Diabetic retinopathy graded by the modified Davis classification · 848x848 · nonmydriatic · 45° FOV · acquired with a NIDEK AFC-230: 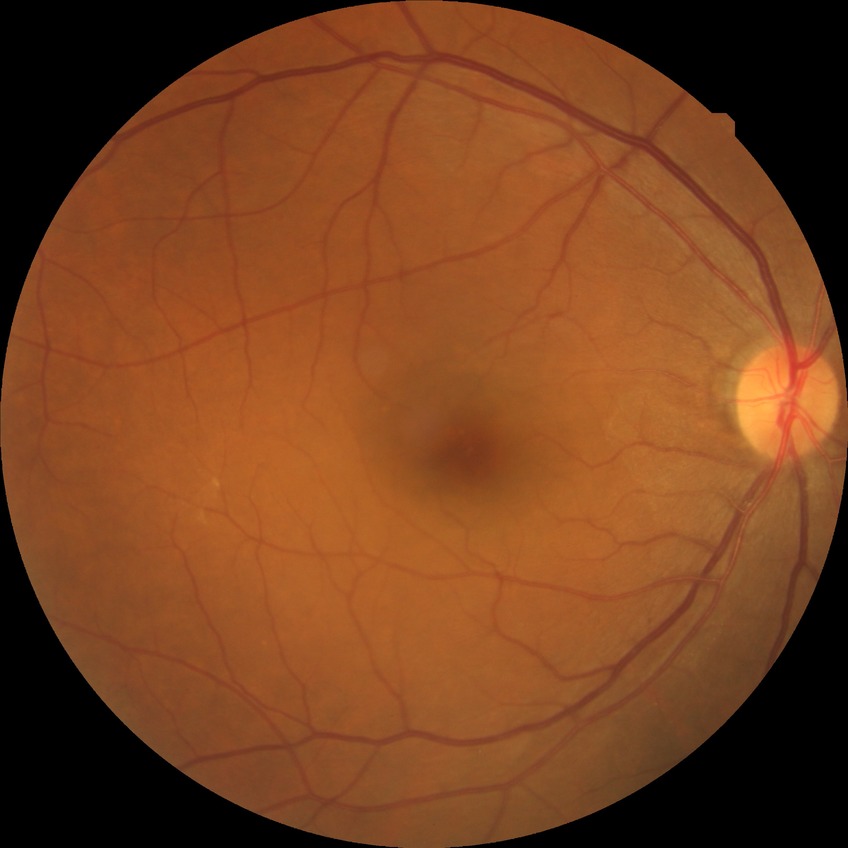
Findings:
* diabetic retinopathy (DR) — no diabetic retinopathy (NDR)